Without pupil dilation; 848x848px; retinal fundus photograph; 45° field of view; camera: NIDEK AFC-230.
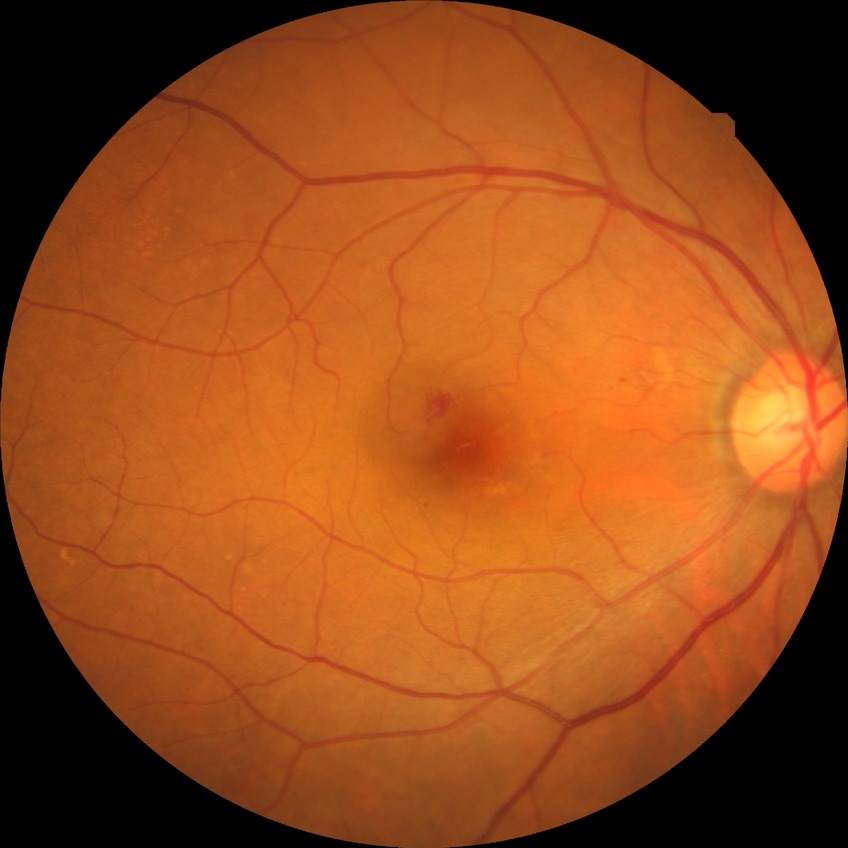 Diabetic retinopathy (DR): SDR (simple diabetic retinopathy). Disease class: non-proliferative diabetic retinopathy.